Phoenix ICON wide-field infant fundus image:
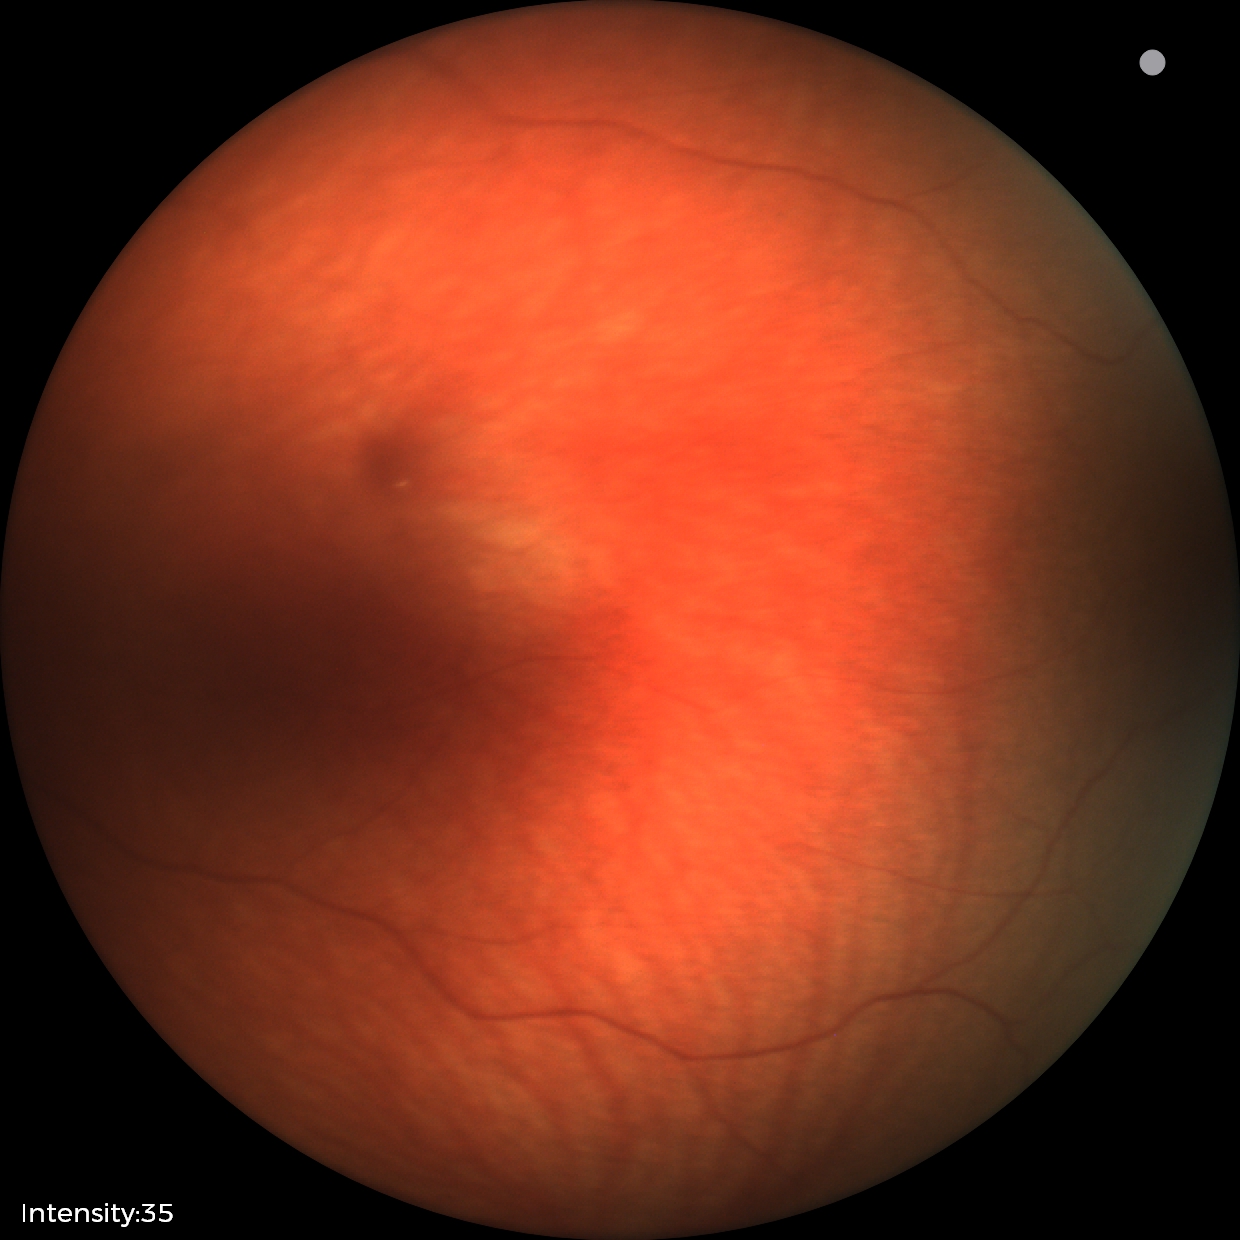
No retinal pathology identified on screening.